Optic disc-centered crop from a color fundus photograph:
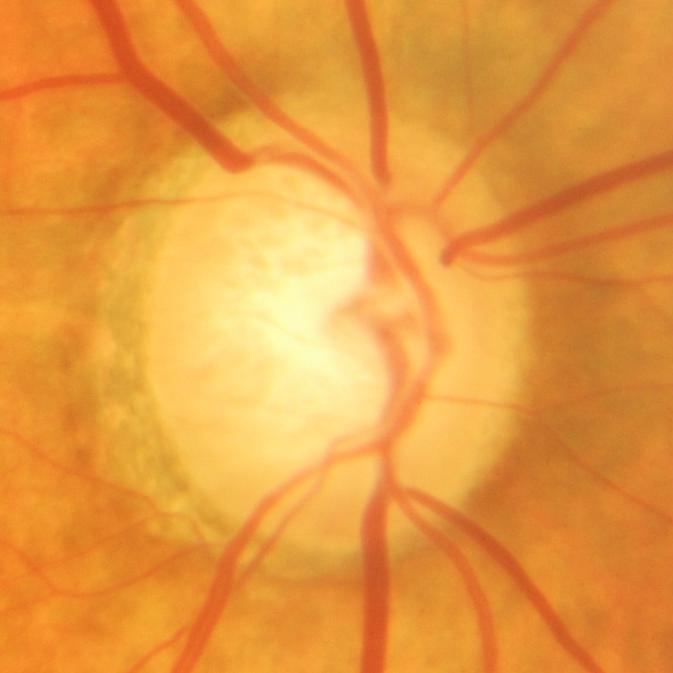 Glaucomatous optic neuropathy is present. Glaucoma status: glaucomatous damage to the optic nerve.